Image size 2212x1661 · Topcon TRC-NW400.
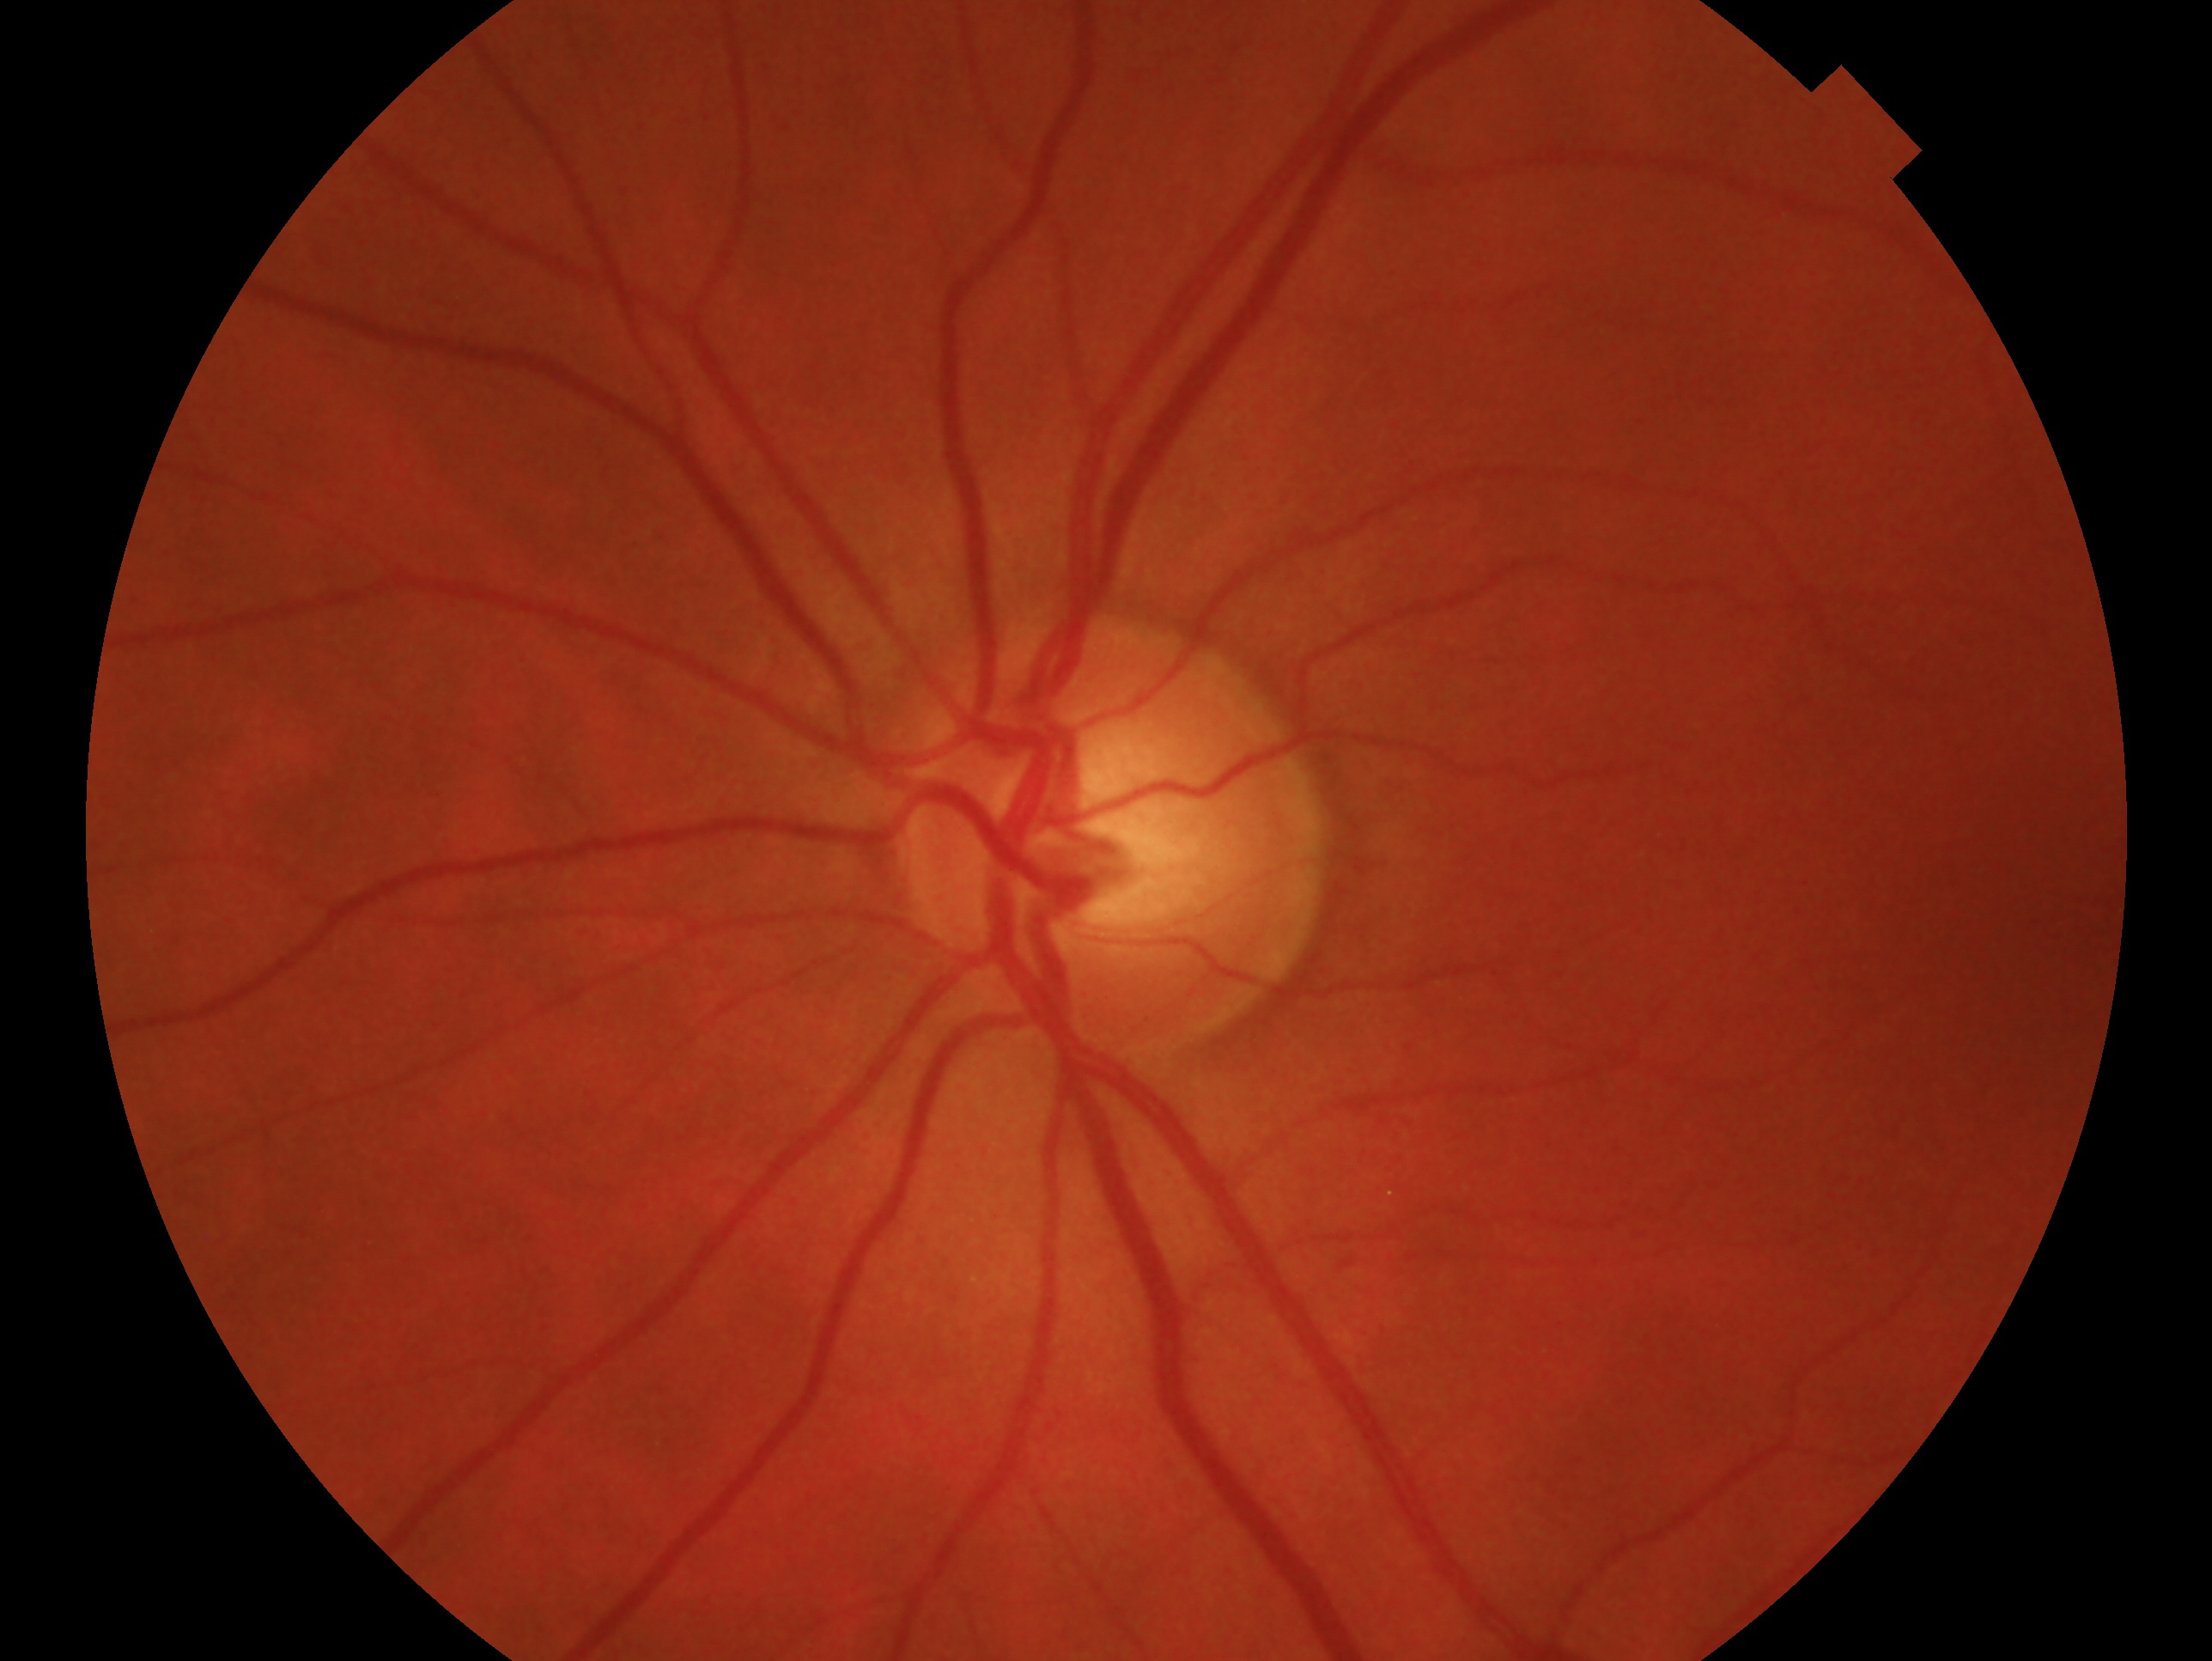

clinical classification = negative for glaucoma
laterality = left eye